848 by 848 pixels; color fundus photograph; acquired with a NIDEK AFC-230; no pharmacologic dilation:
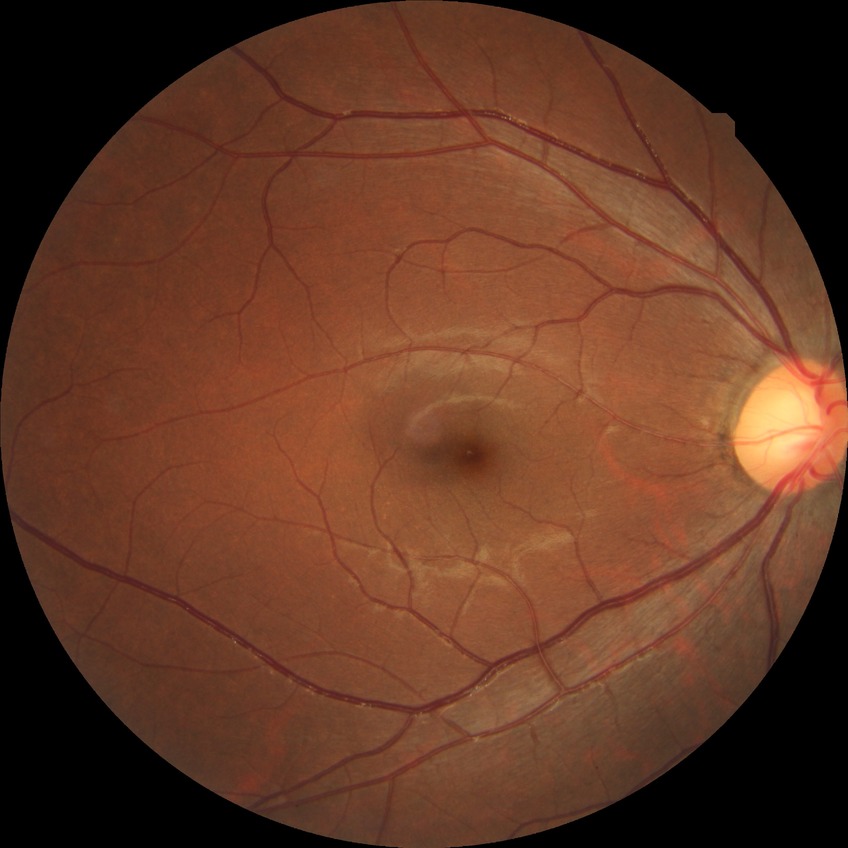

  davis_grade: no diabetic retinopathy